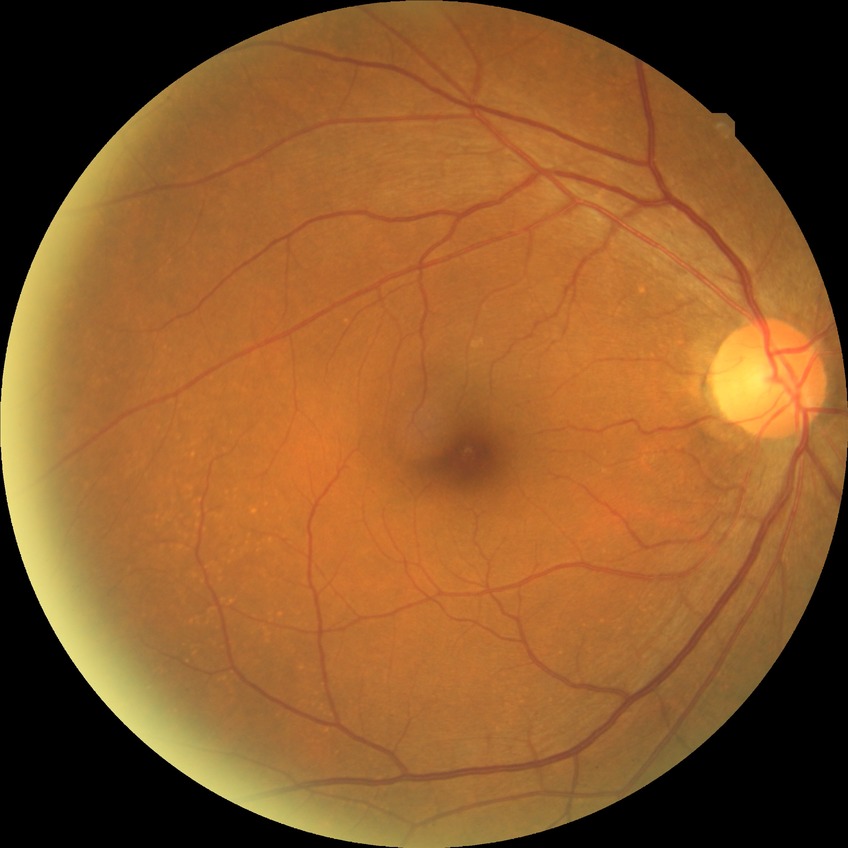

Findings:
* DR stage — NDR
* DR impression — no DR findings